45° field of view.
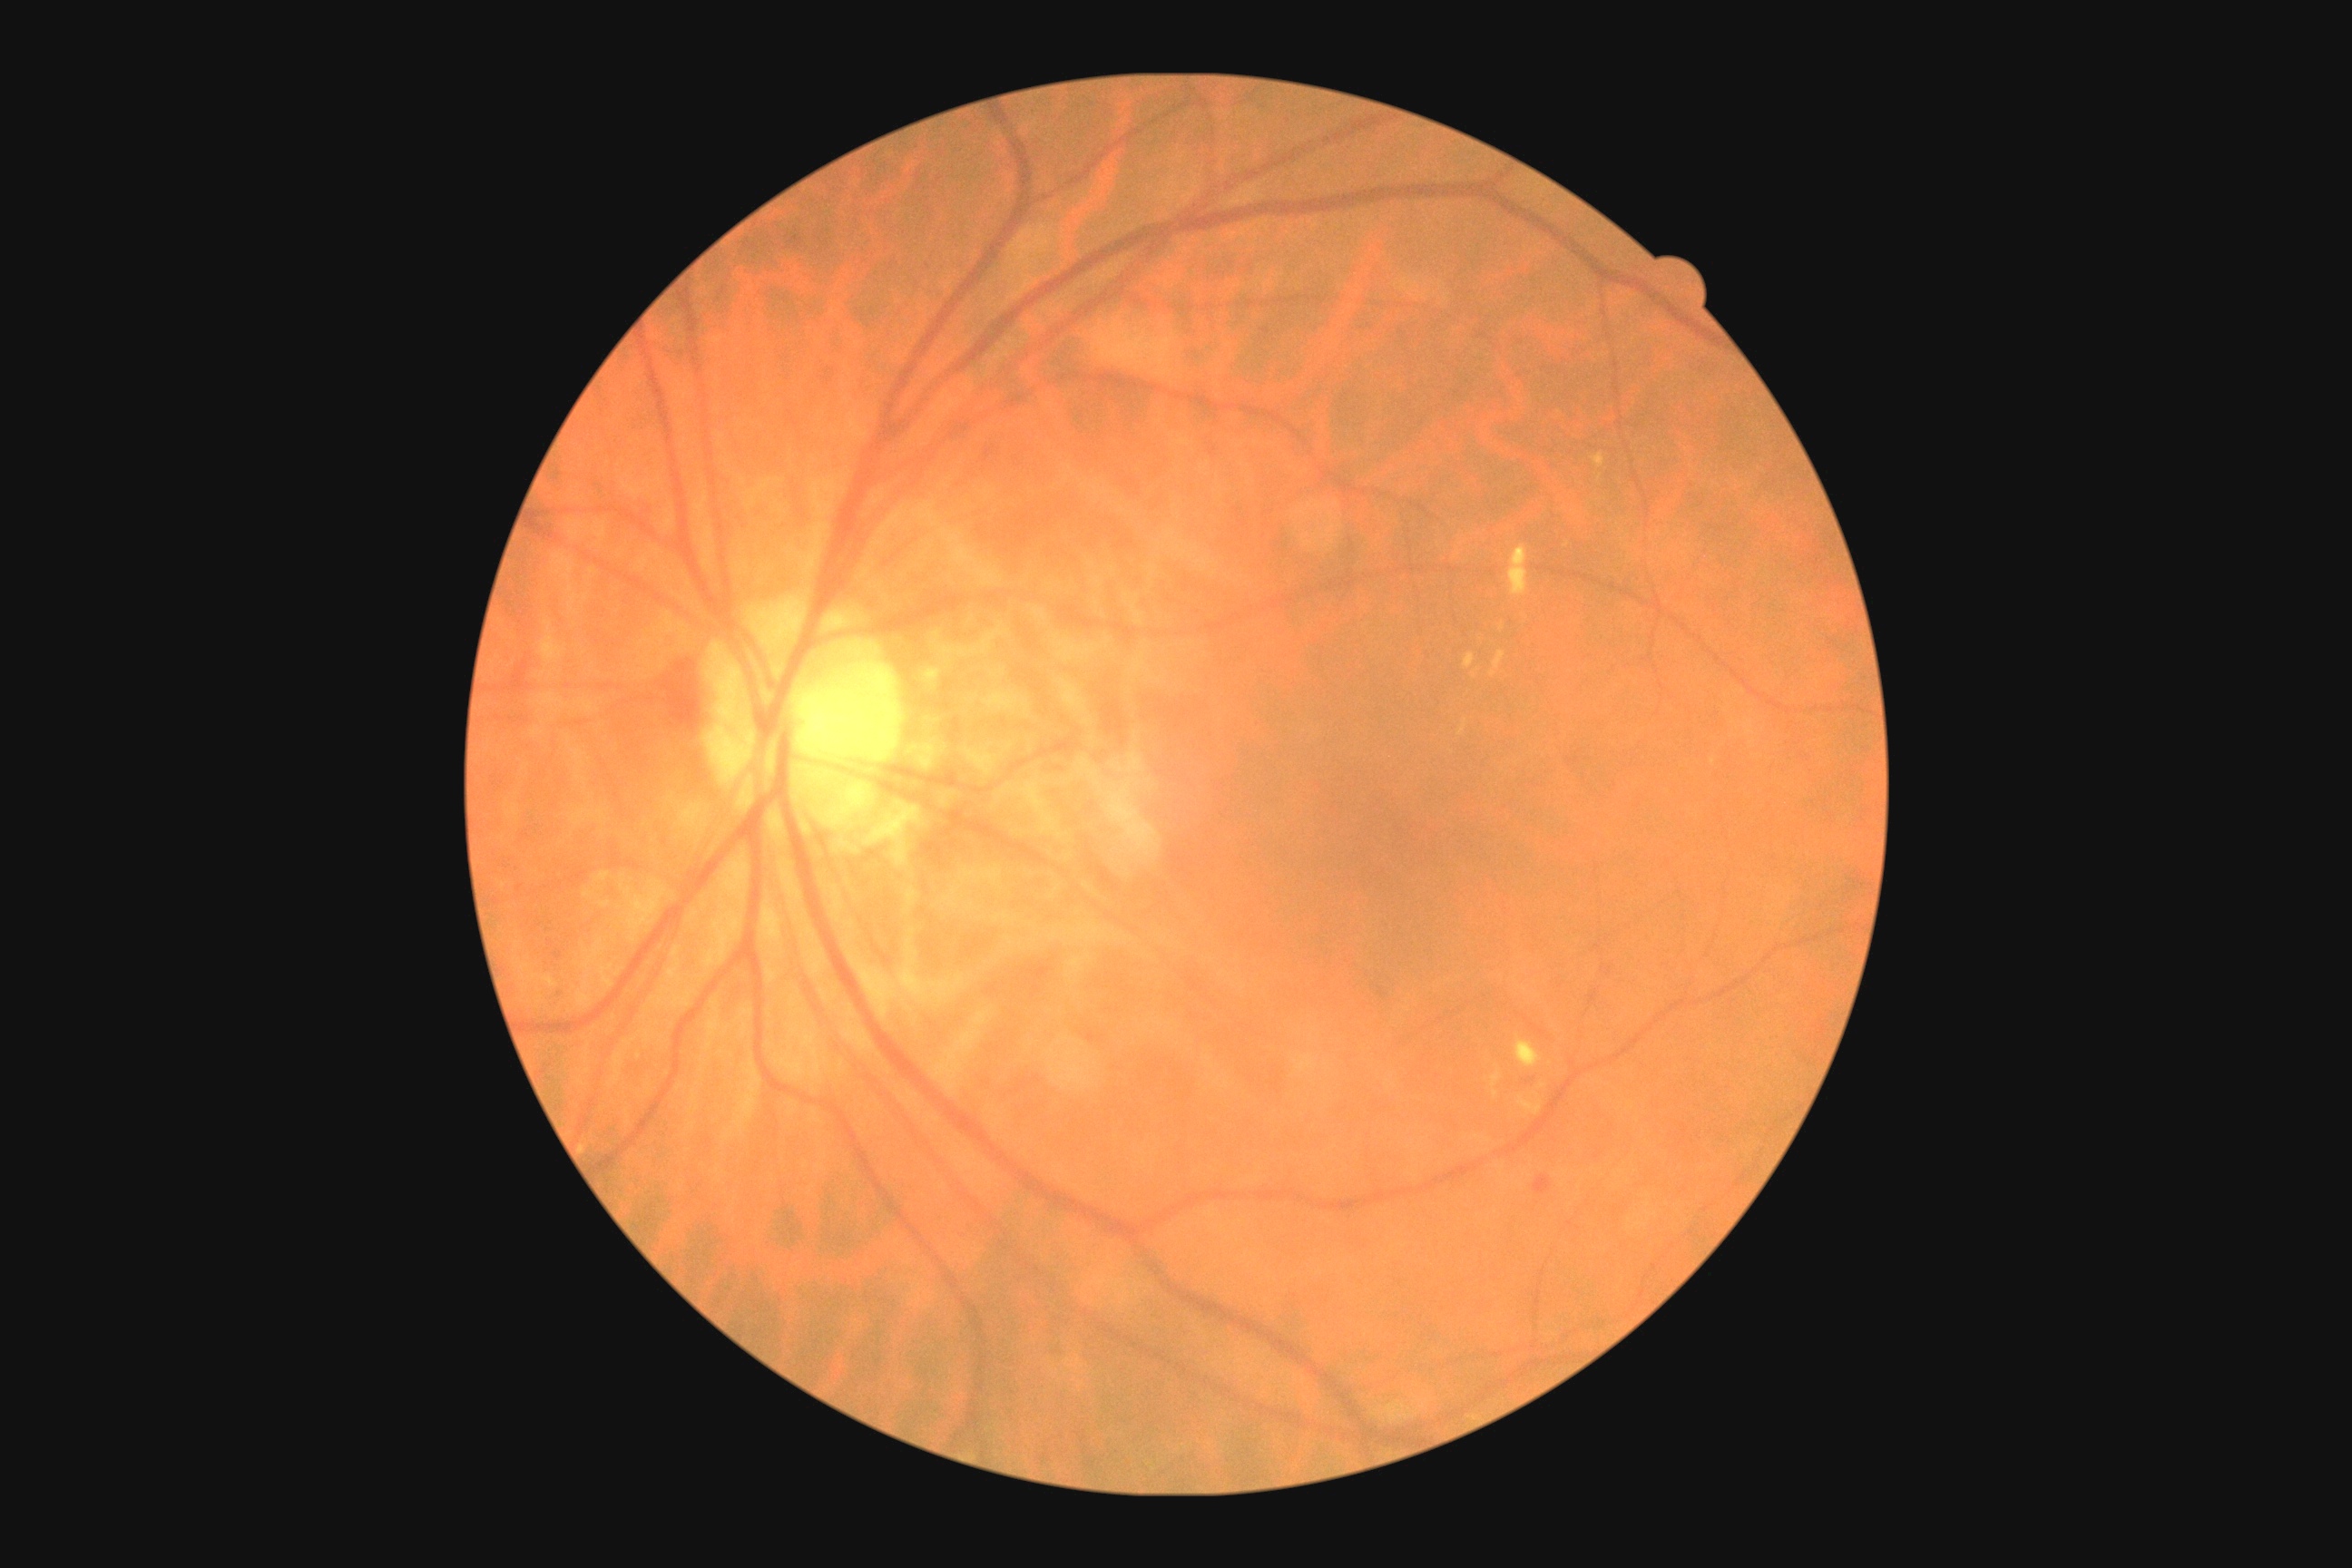 Diabetic retinopathy (DR): moderate non-proliferative diabetic retinopathy (grade 2)
Selected lesions:
soft exudates (SEs): not present
hard exudates (EXs) (more not shown): [x1=1592, y1=453, x2=1605, y2=467]; [x1=1458, y1=720, x2=1467, y2=736]; [x1=1514, y1=1037, x2=1544, y2=1068]; [x1=1509, y1=545, x2=1529, y2=596]; [x1=1464, y1=654, x2=1475, y2=669]; [x1=1518, y1=1095, x2=1544, y2=1115]; [x1=1491, y1=651, x2=1505, y2=678]; [x1=1493, y1=1090, x2=1498, y2=1099]; [x1=1491, y1=1066, x2=1502, y2=1086]; [x1=1500, y1=623, x2=1504, y2=631]
EXs (small, approximate centers) near <point>1474, 676</point>; <point>1542, 1086</point>; <point>1600, 478</point>; <point>1567, 546</point>
hemorrhages (HEs): [x1=513, y1=654, x2=531, y2=680]; [x1=1533, y1=1175, x2=1553, y2=1195]; [x1=665, y1=649, x2=703, y2=729]
microaneurysms (MAs) (more not shown): [x1=554, y1=952, x2=564, y2=961]